No pharmacologic dilation: 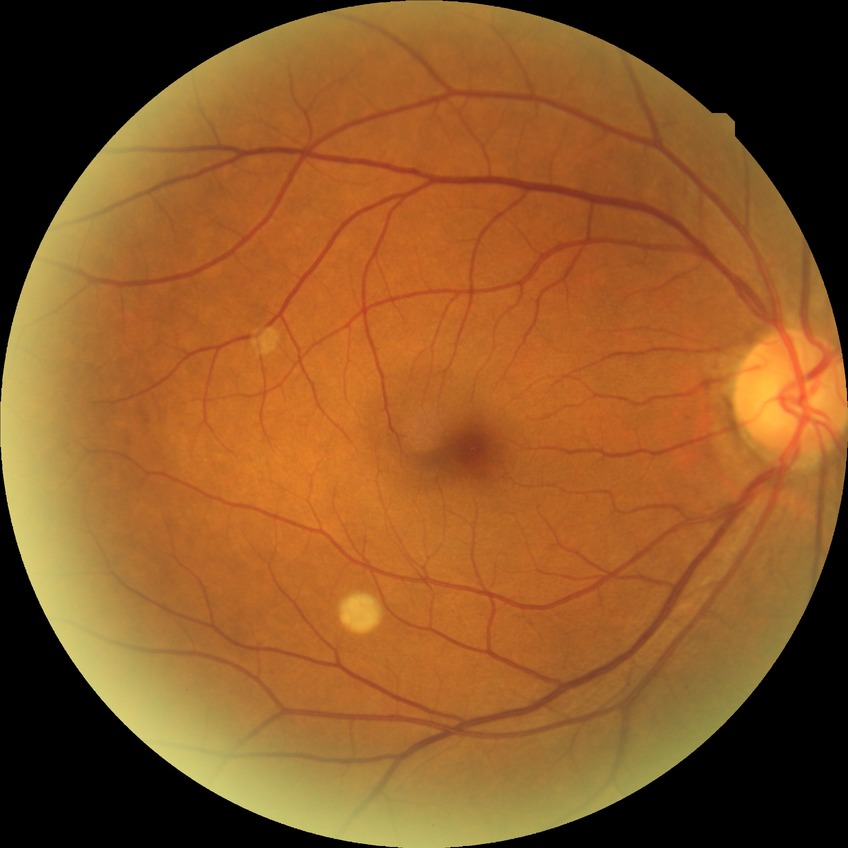

Diabetic retinopathy stage is no diabetic retinopathy.